Wide-field fundus photograph of an infant — 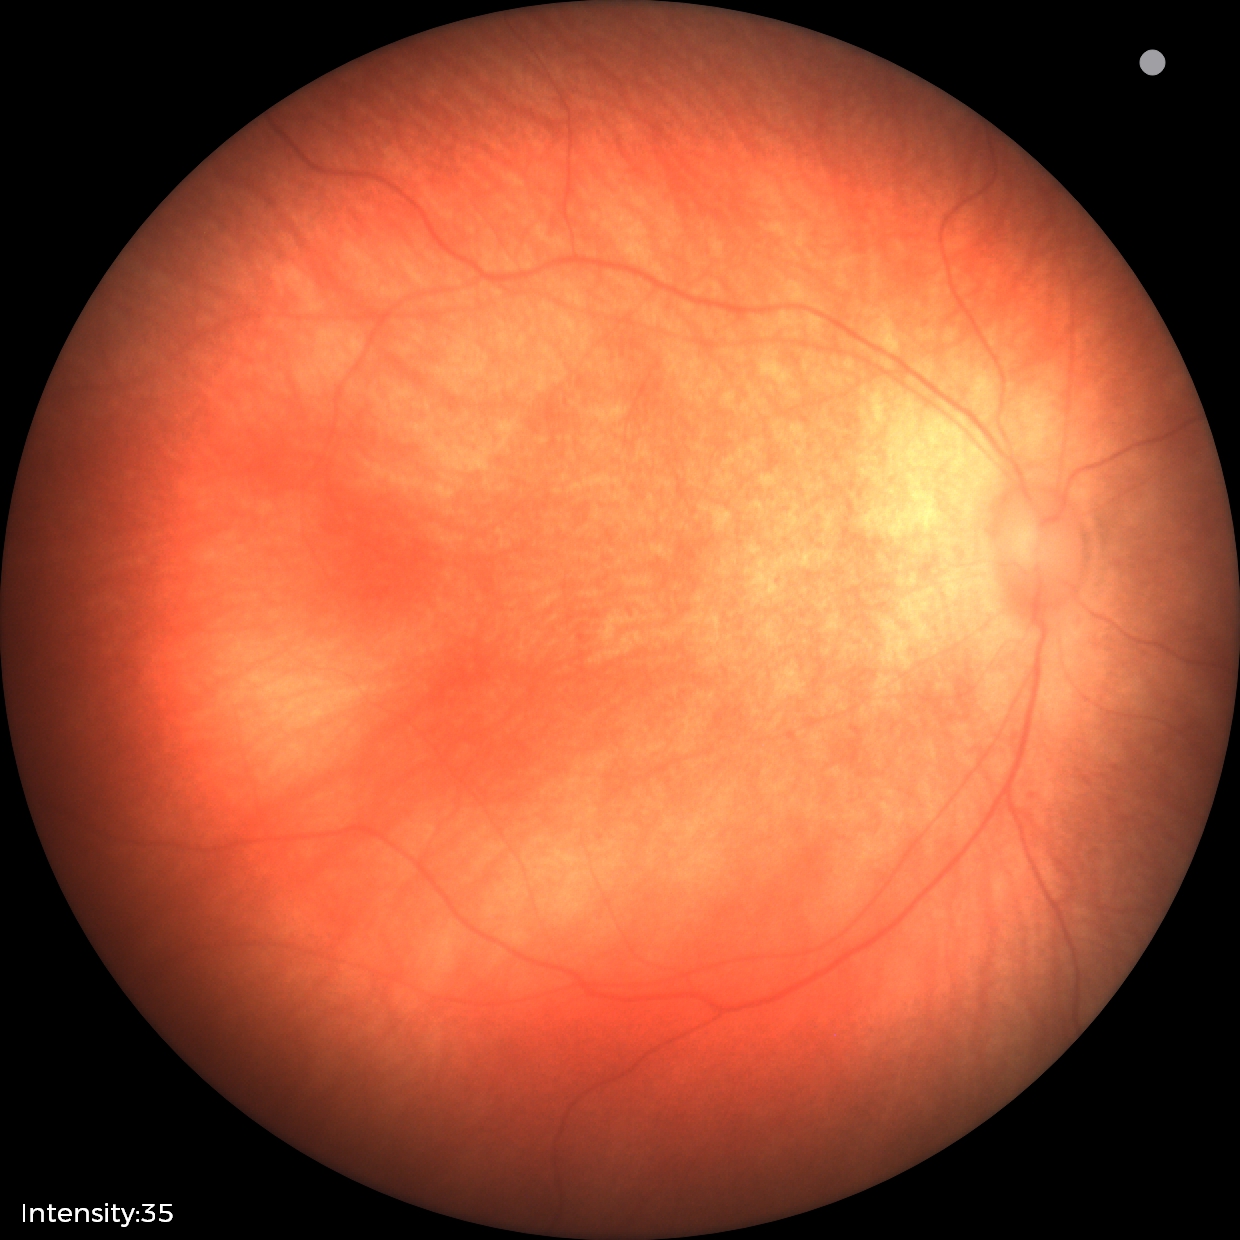 Assessment: physiological finding.